Posterior pole color fundus photograph; without pupil dilation; 45-degree field of view; 848 by 848 pixels; acquired with a NIDEK AFC-230 — 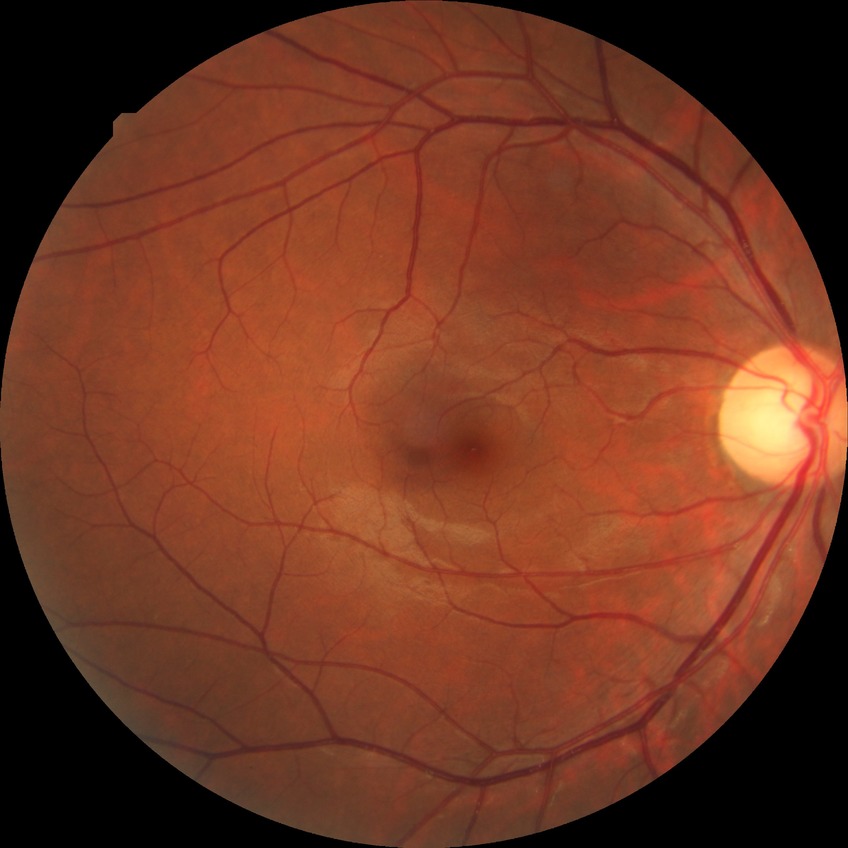
modified Davis classification@no diabetic retinopathy.